45-degree field of view. Color fundus image. 2352x1568px: 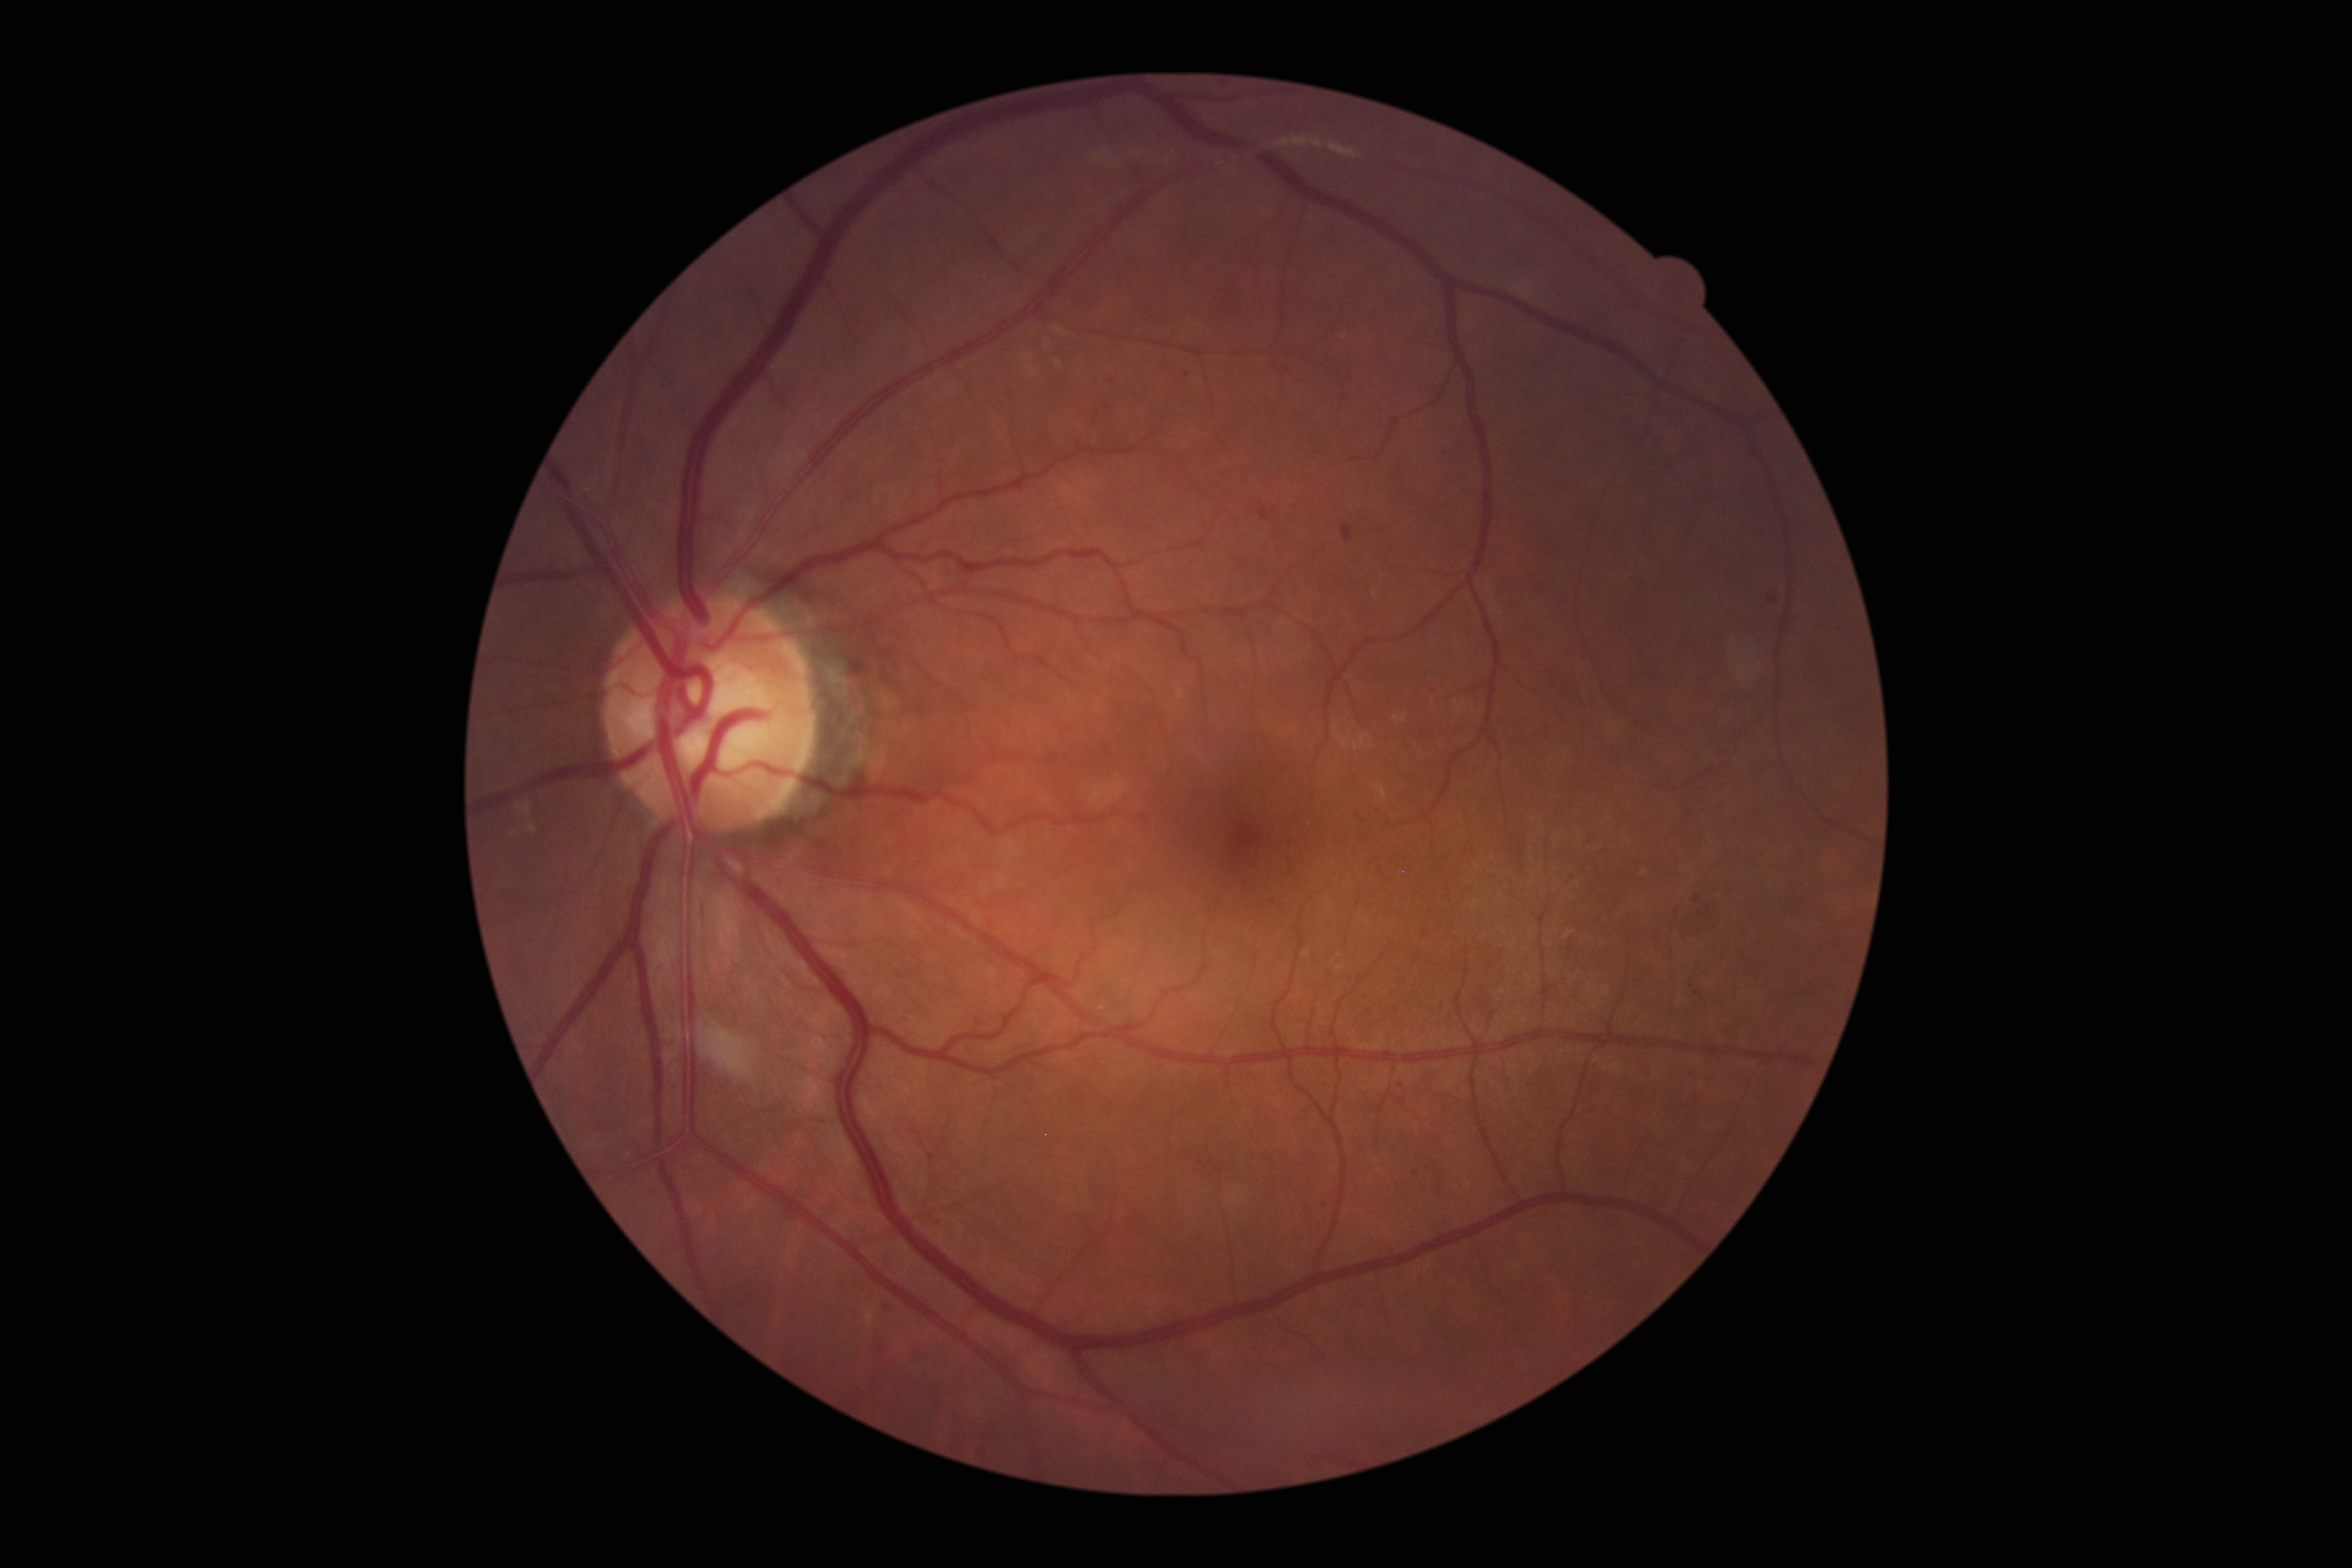

Diabetic retinopathy (DR): 1. Hemorrhages (HEs) (partial list) at <box>1693,895,1700,903</box>; <box>883,1302,903,1319</box>; <box>1259,511,1270,521</box>; <box>1105,403,1112,411</box>; <box>1767,596,1777,604</box>; <box>1341,523,1353,541</box>. Small HEs near 1401, 1086; 1696, 994; 1416, 1175; 982, 1452; 1113, 381; 1700, 914; 1187, 374; 1326, 1205; 1693, 985; 1273, 902. No soft exudates (SEs) identified. No hard exudates (EXs) identified. No microaneurysms (MAs) identified.